Wide-field fundus image from infant ROP screening. 1240 by 1240 pixels:
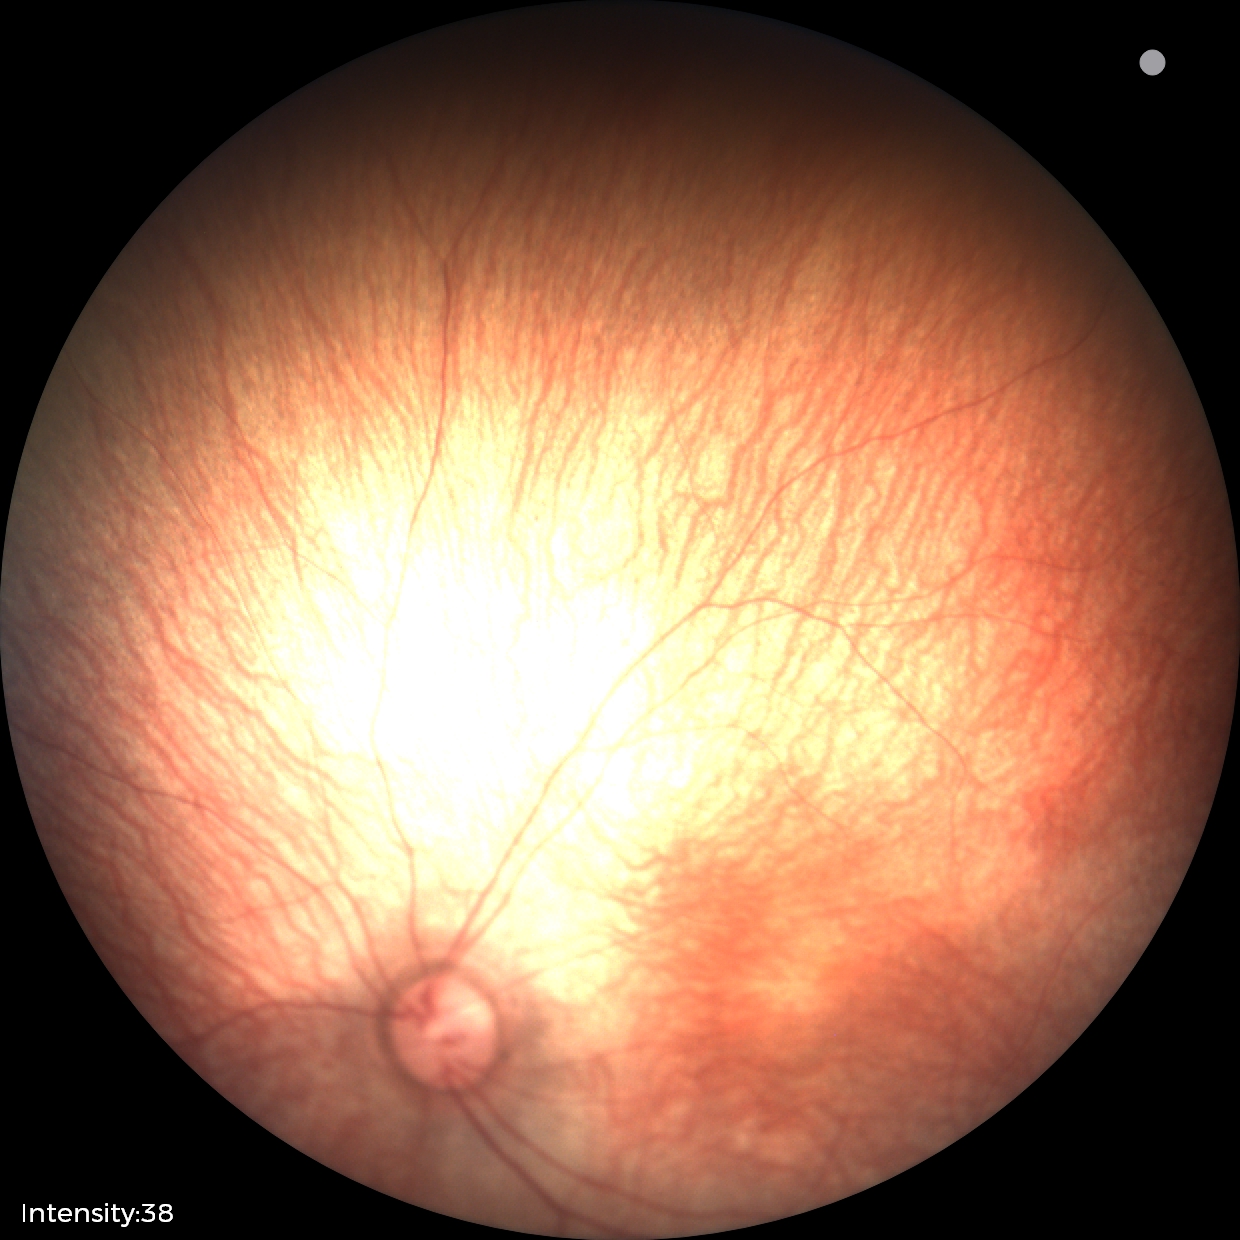 Screening examination diagnosed as physiological.